Acquired with a Remidio Fundus on Phone, CFP — 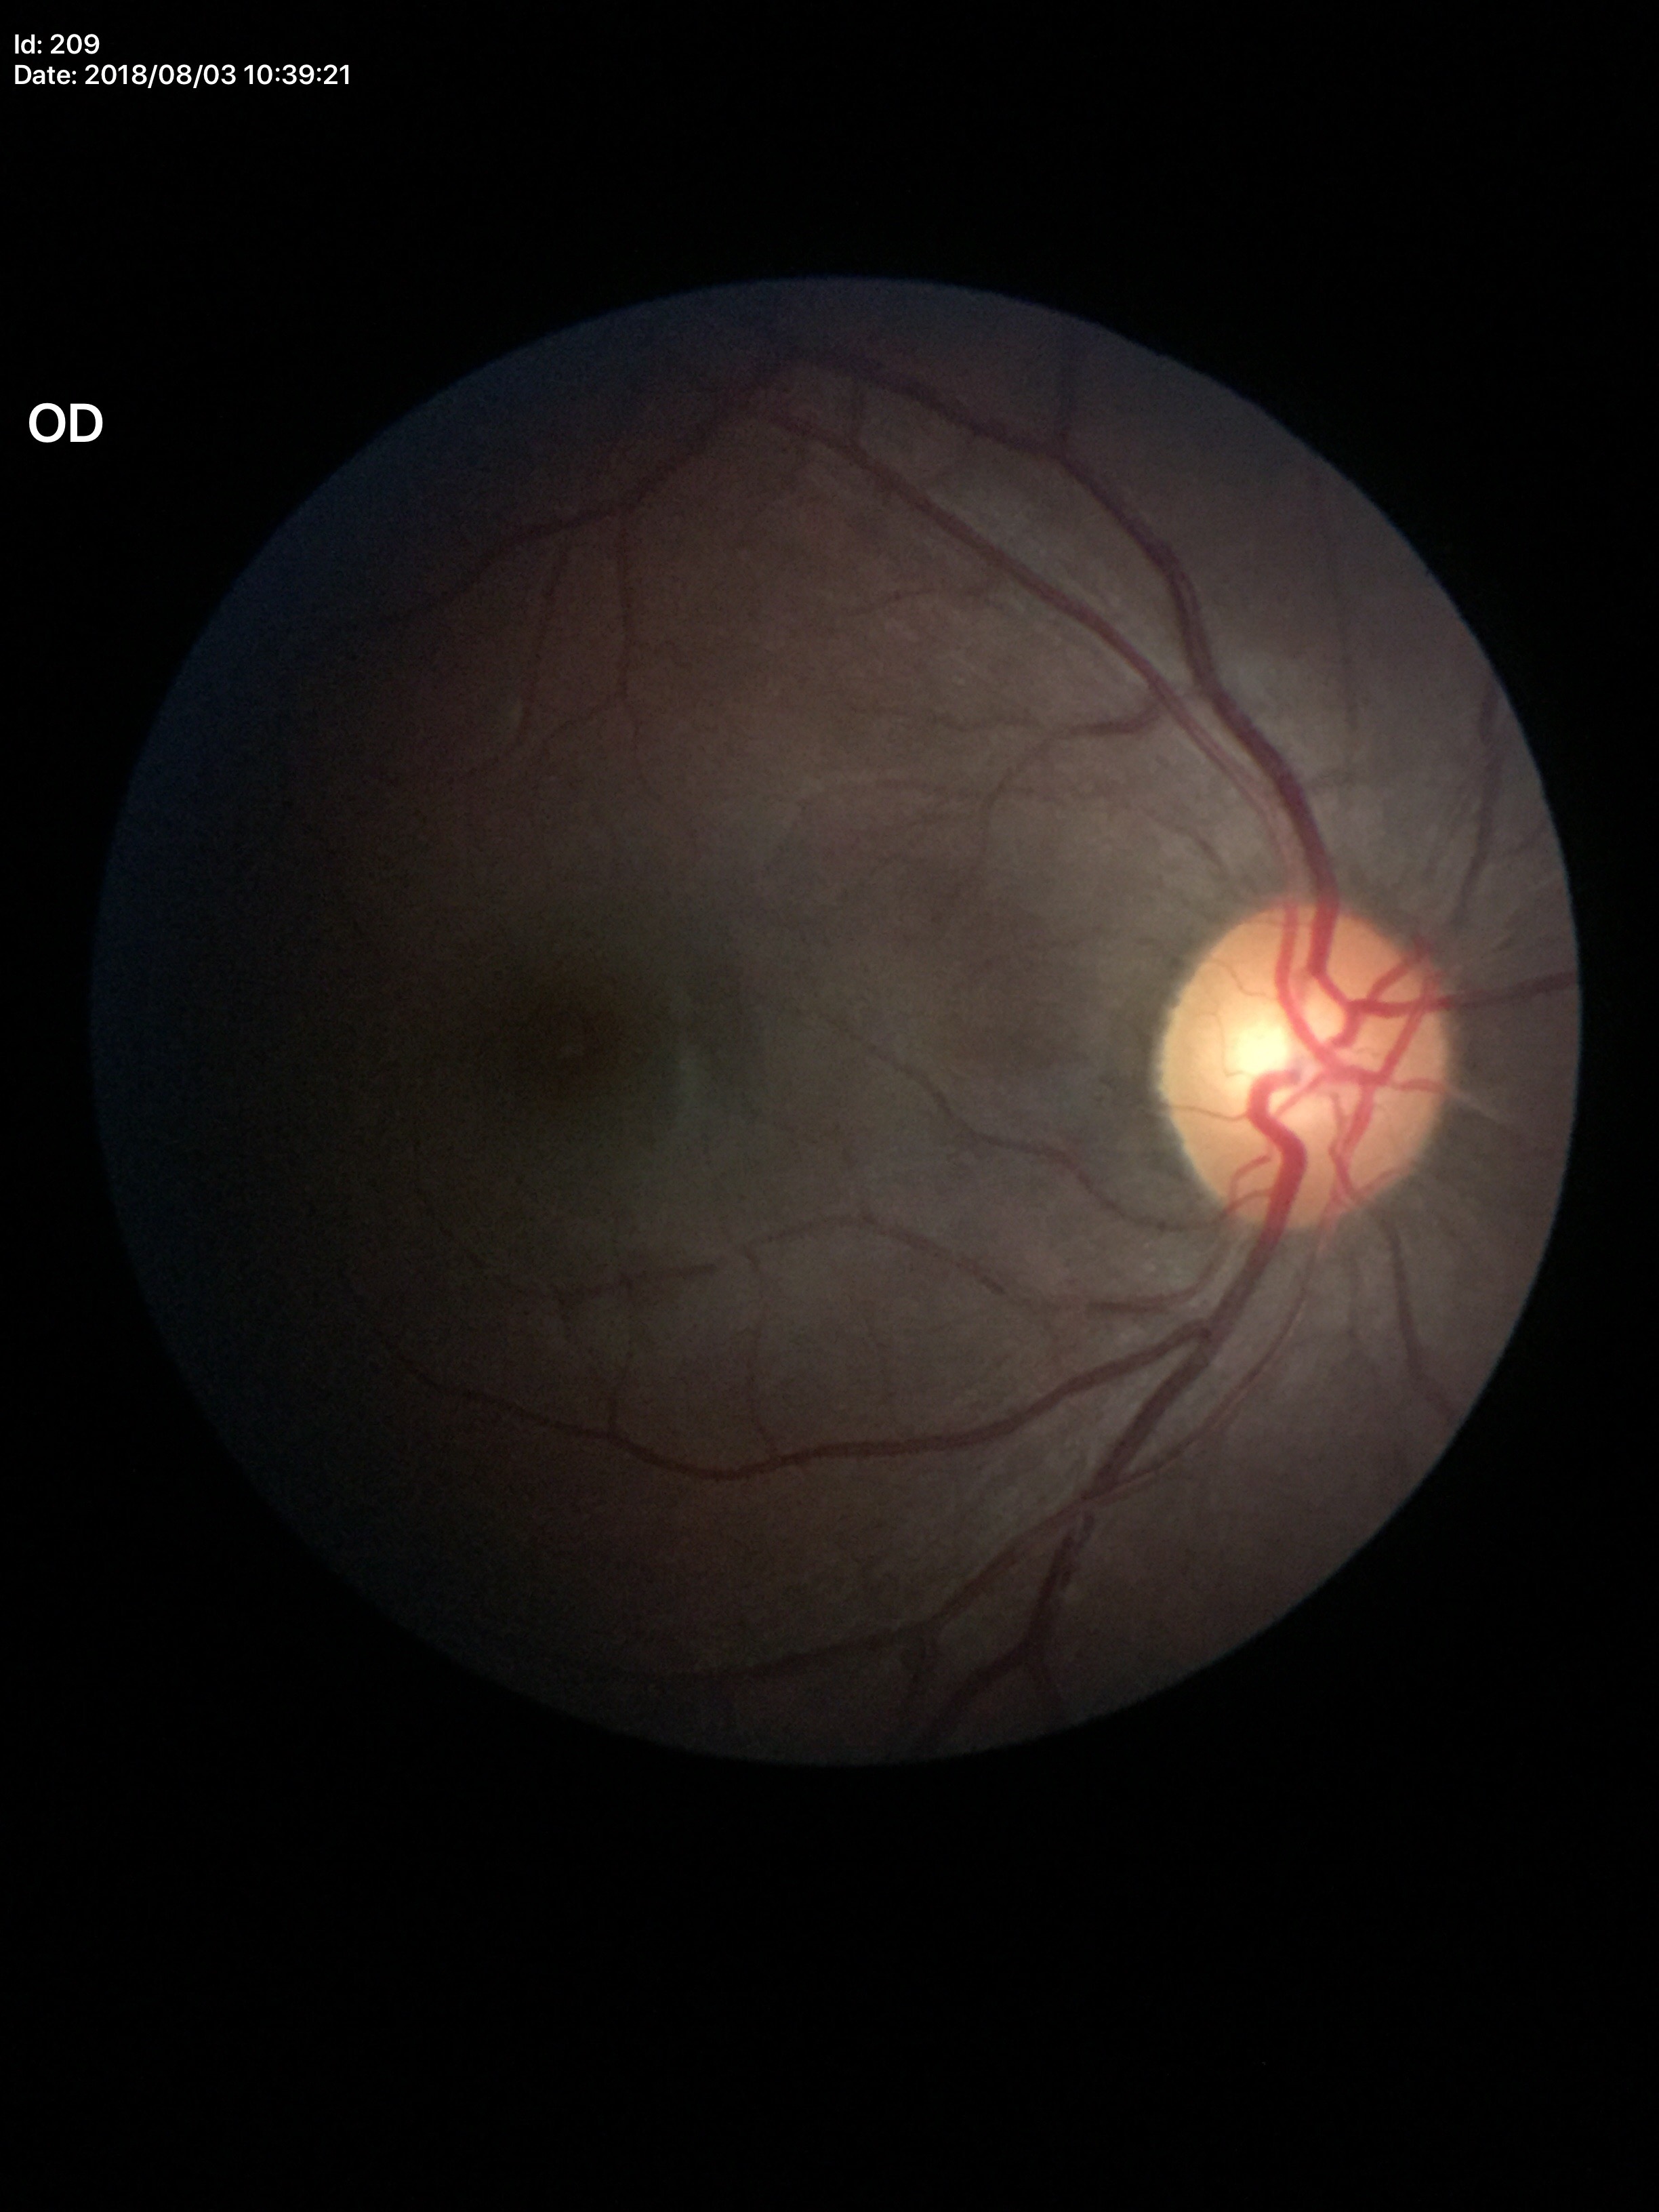

No glaucomatous findings. Vertical cup-to-disc ratio is 0.49.